Modified Davis grading. Without pupil dilation. NIDEK AFC-230:
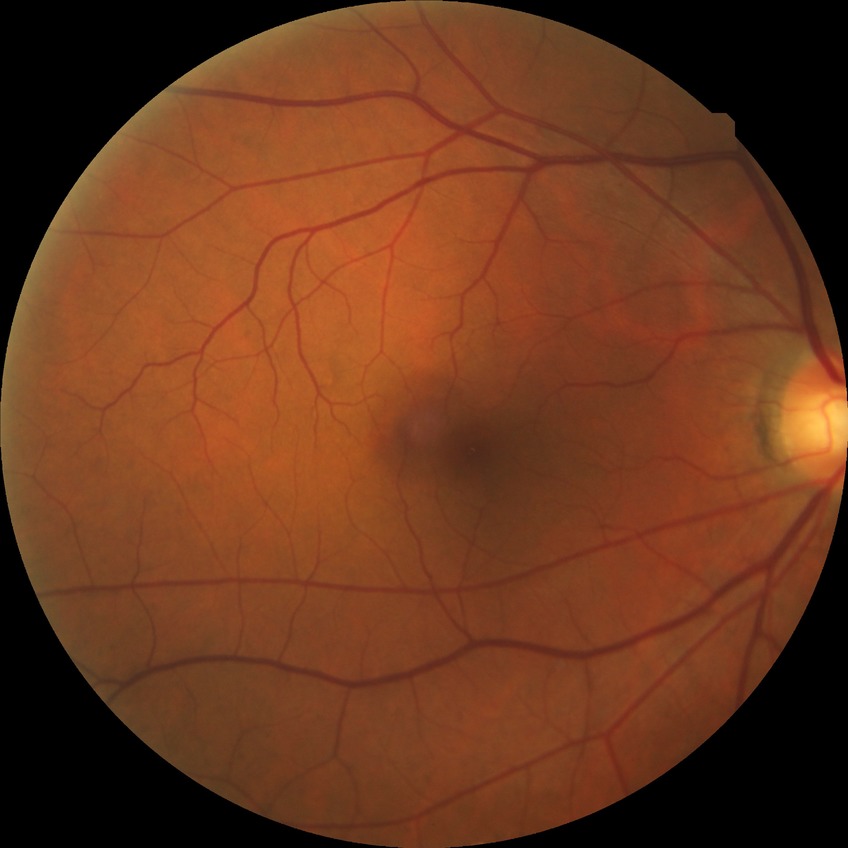 Davis grade = NDR.